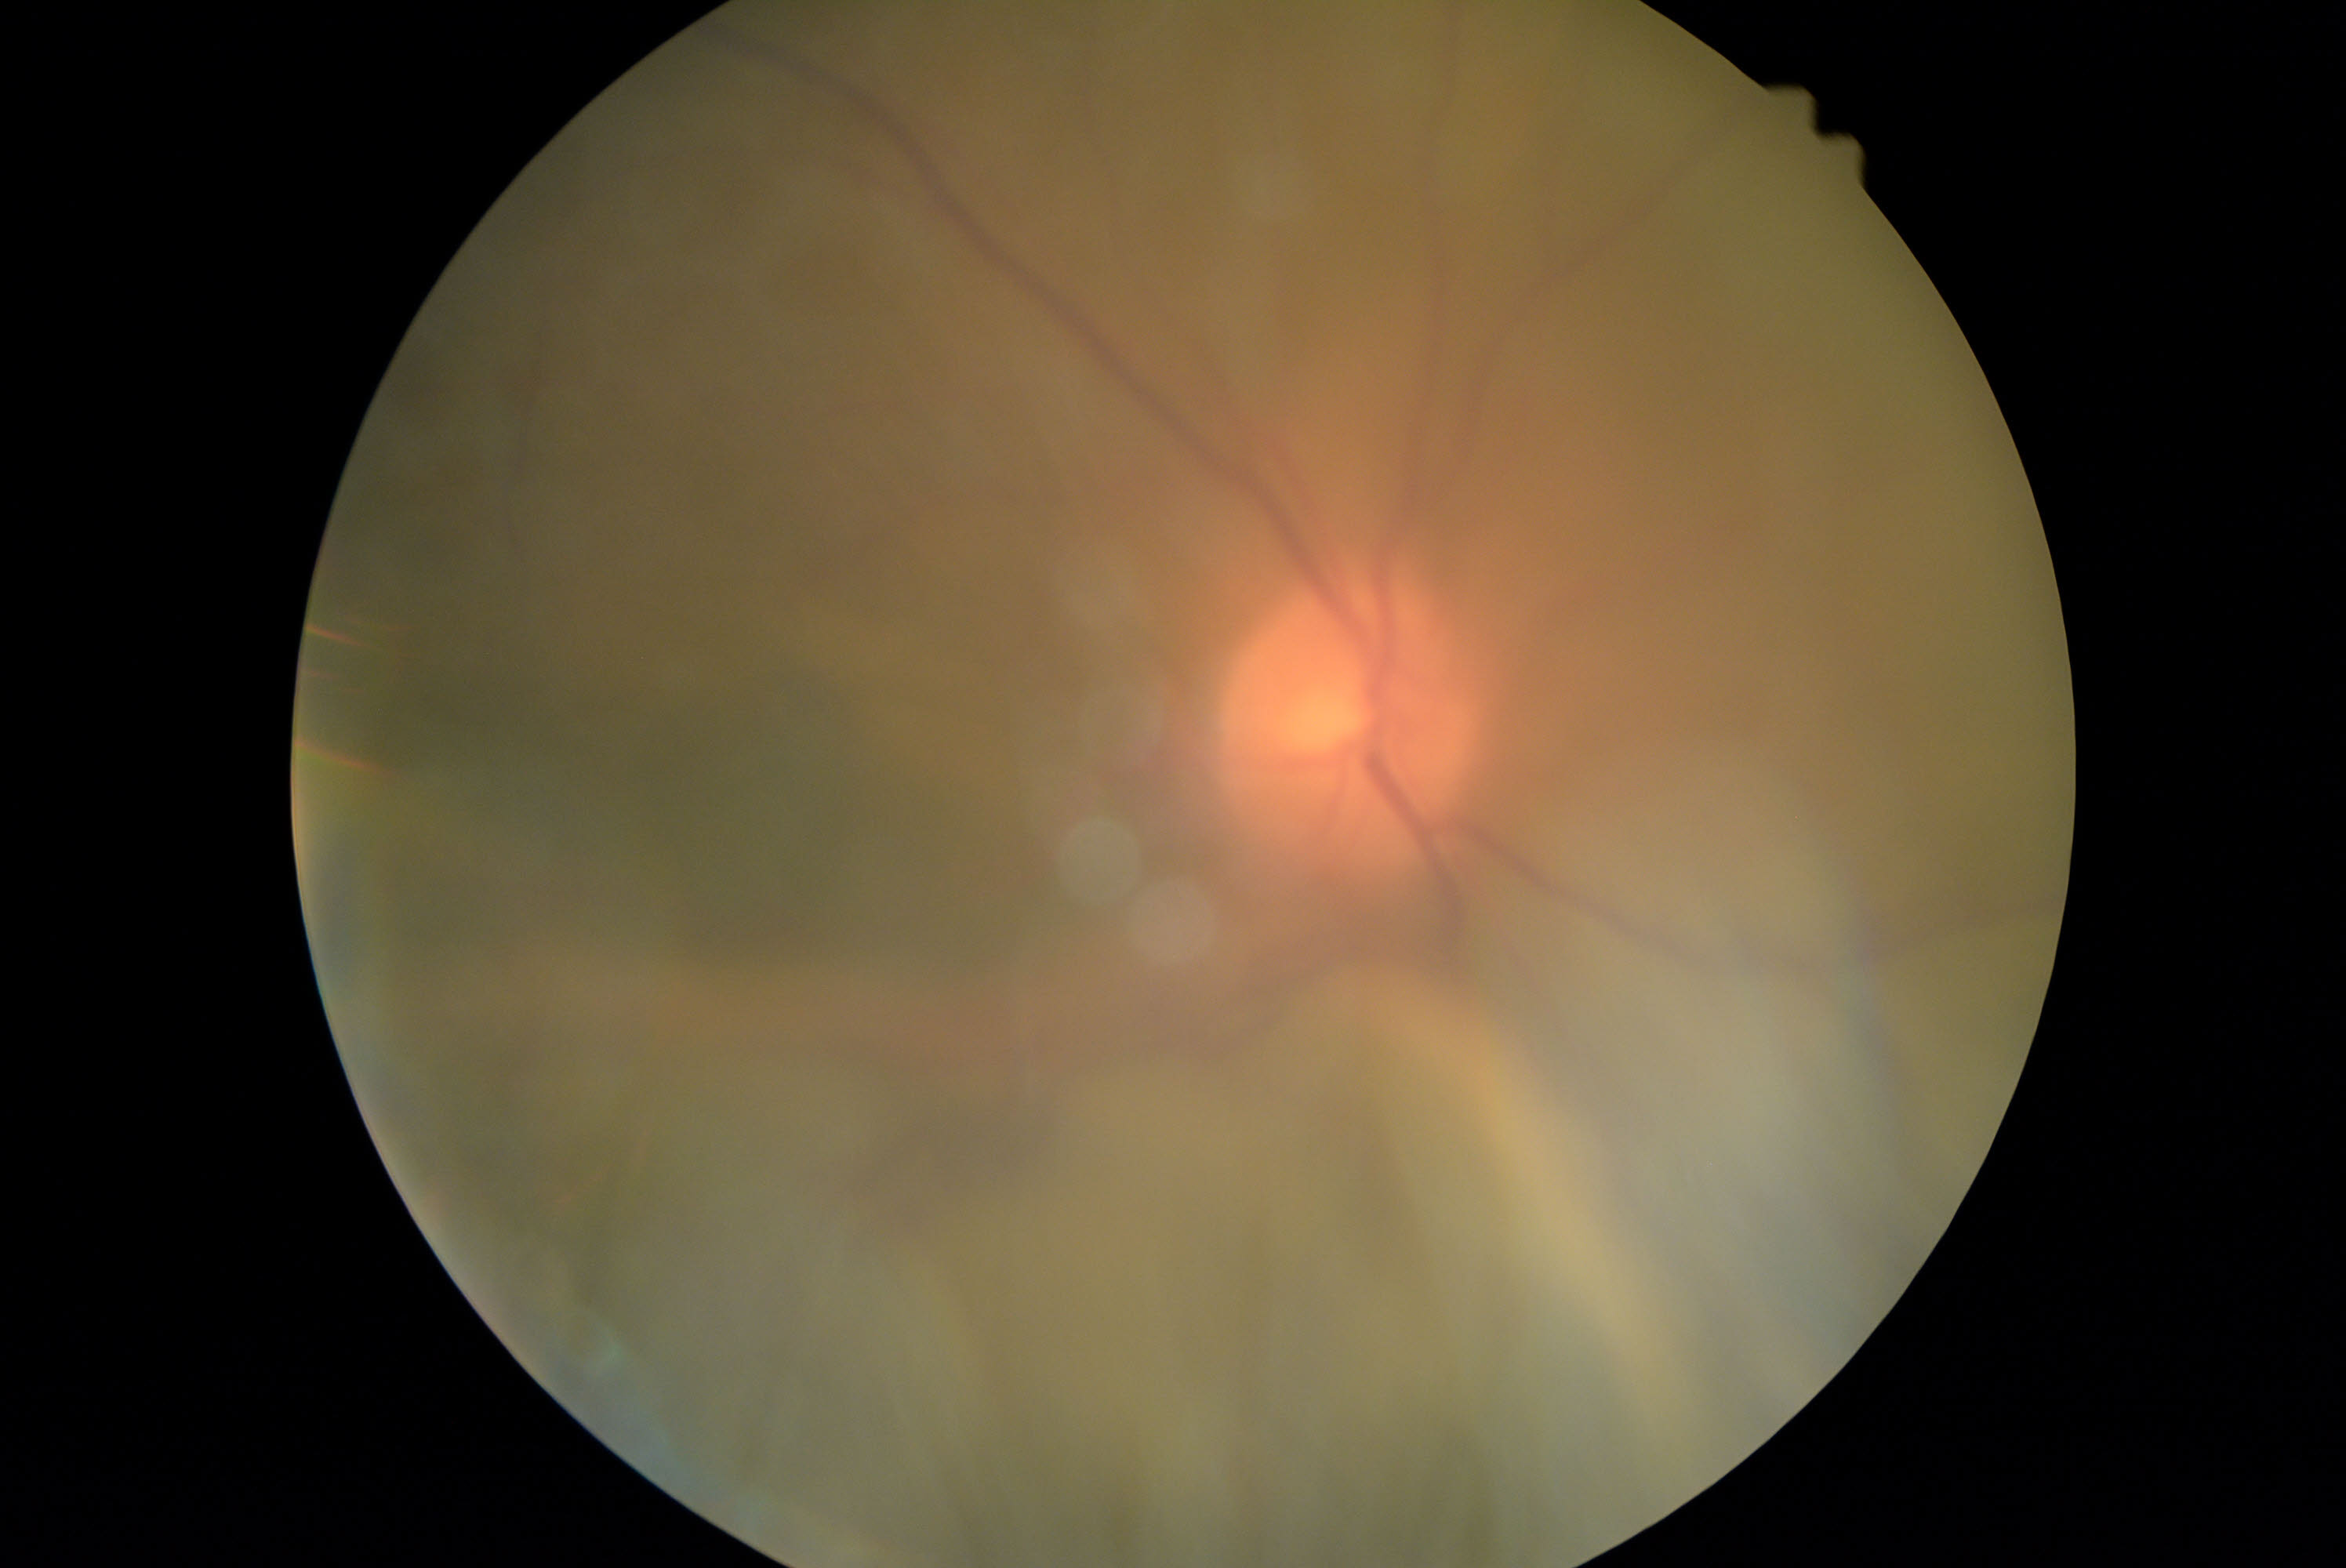

{
  "dr_grade": "ungradable due to poor image quality"
}